Color fundus image: 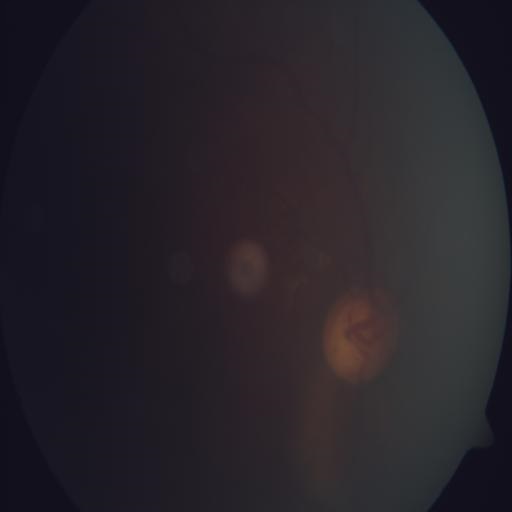
Showing optic disc cupping.